Fundus image cropped to the optic disc: 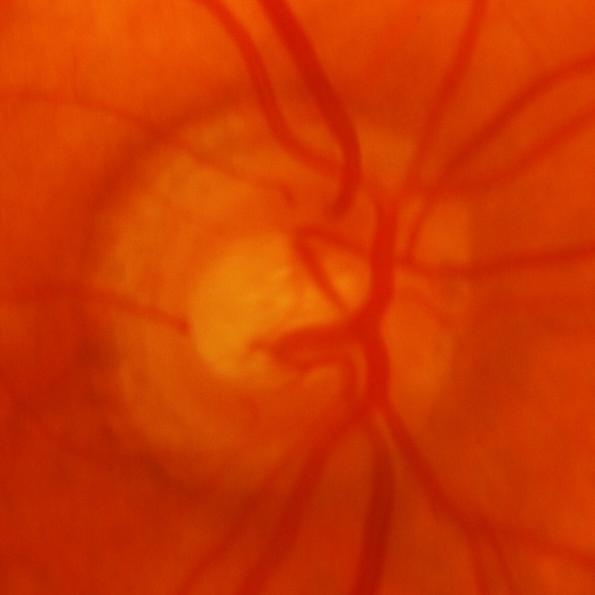

Q: Is there glaucomatous optic neuropathy?
A: Yes — glaucomatous damage to the optic nerve.